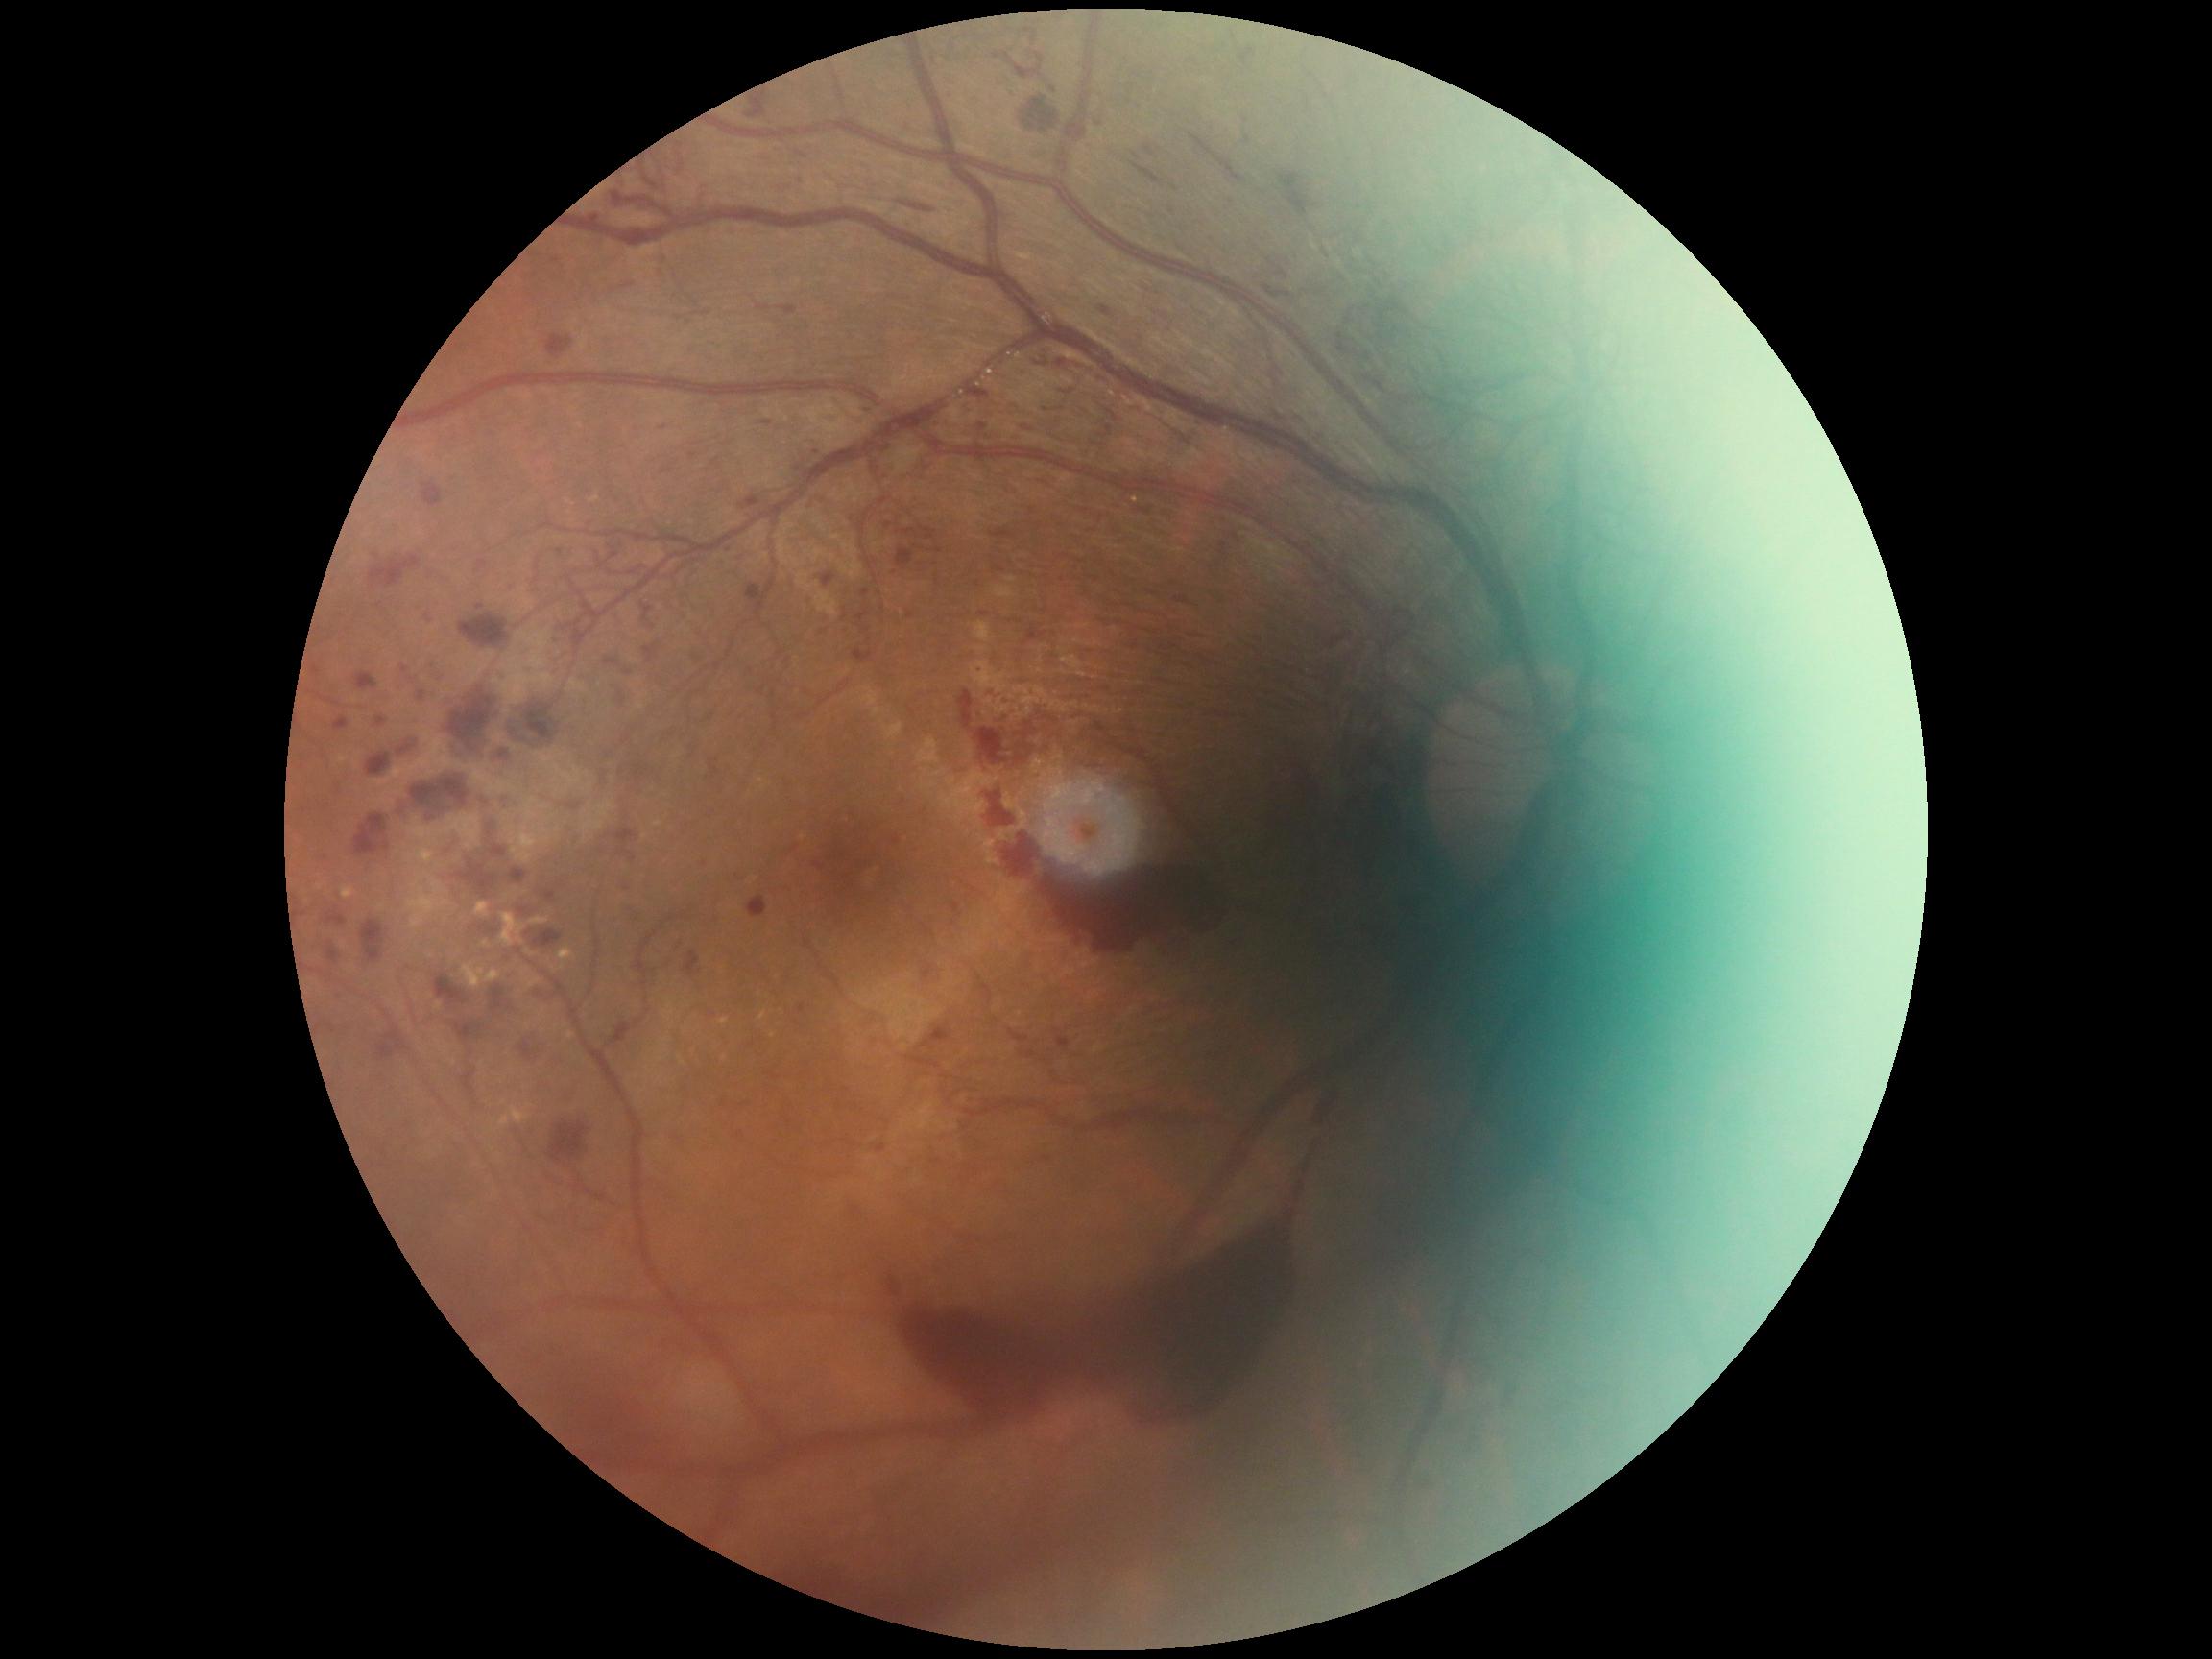 Disease class: proliferative diabetic retinopathy. DR grade is 4/4.